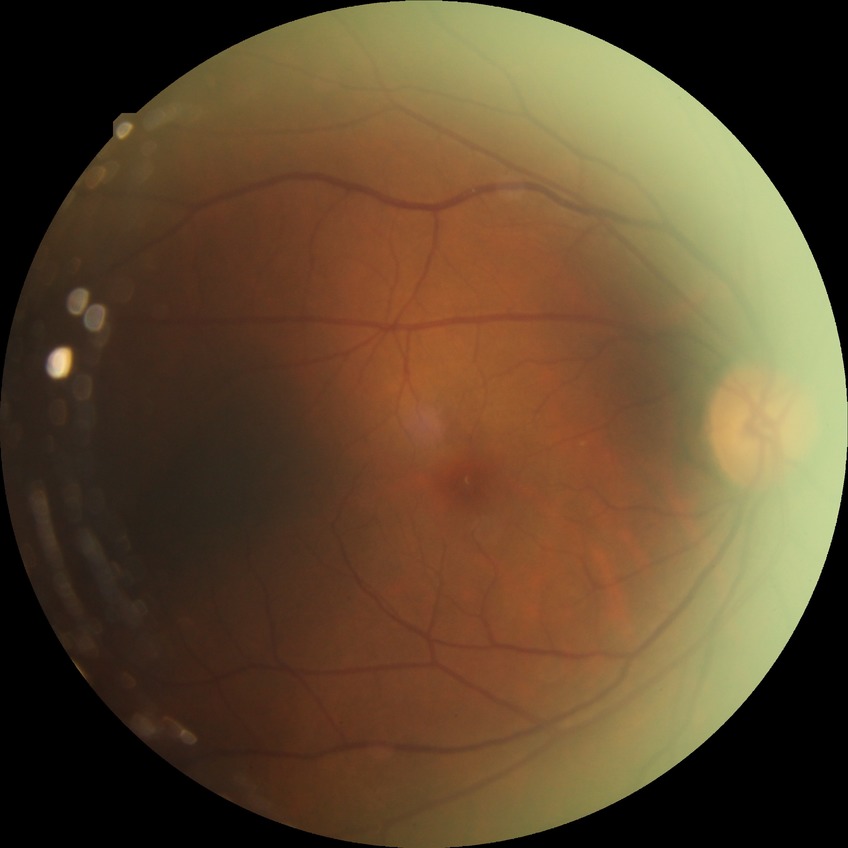 Diabetic retinopathy (DR) is simple diabetic retinopathy (SDR).